CFP
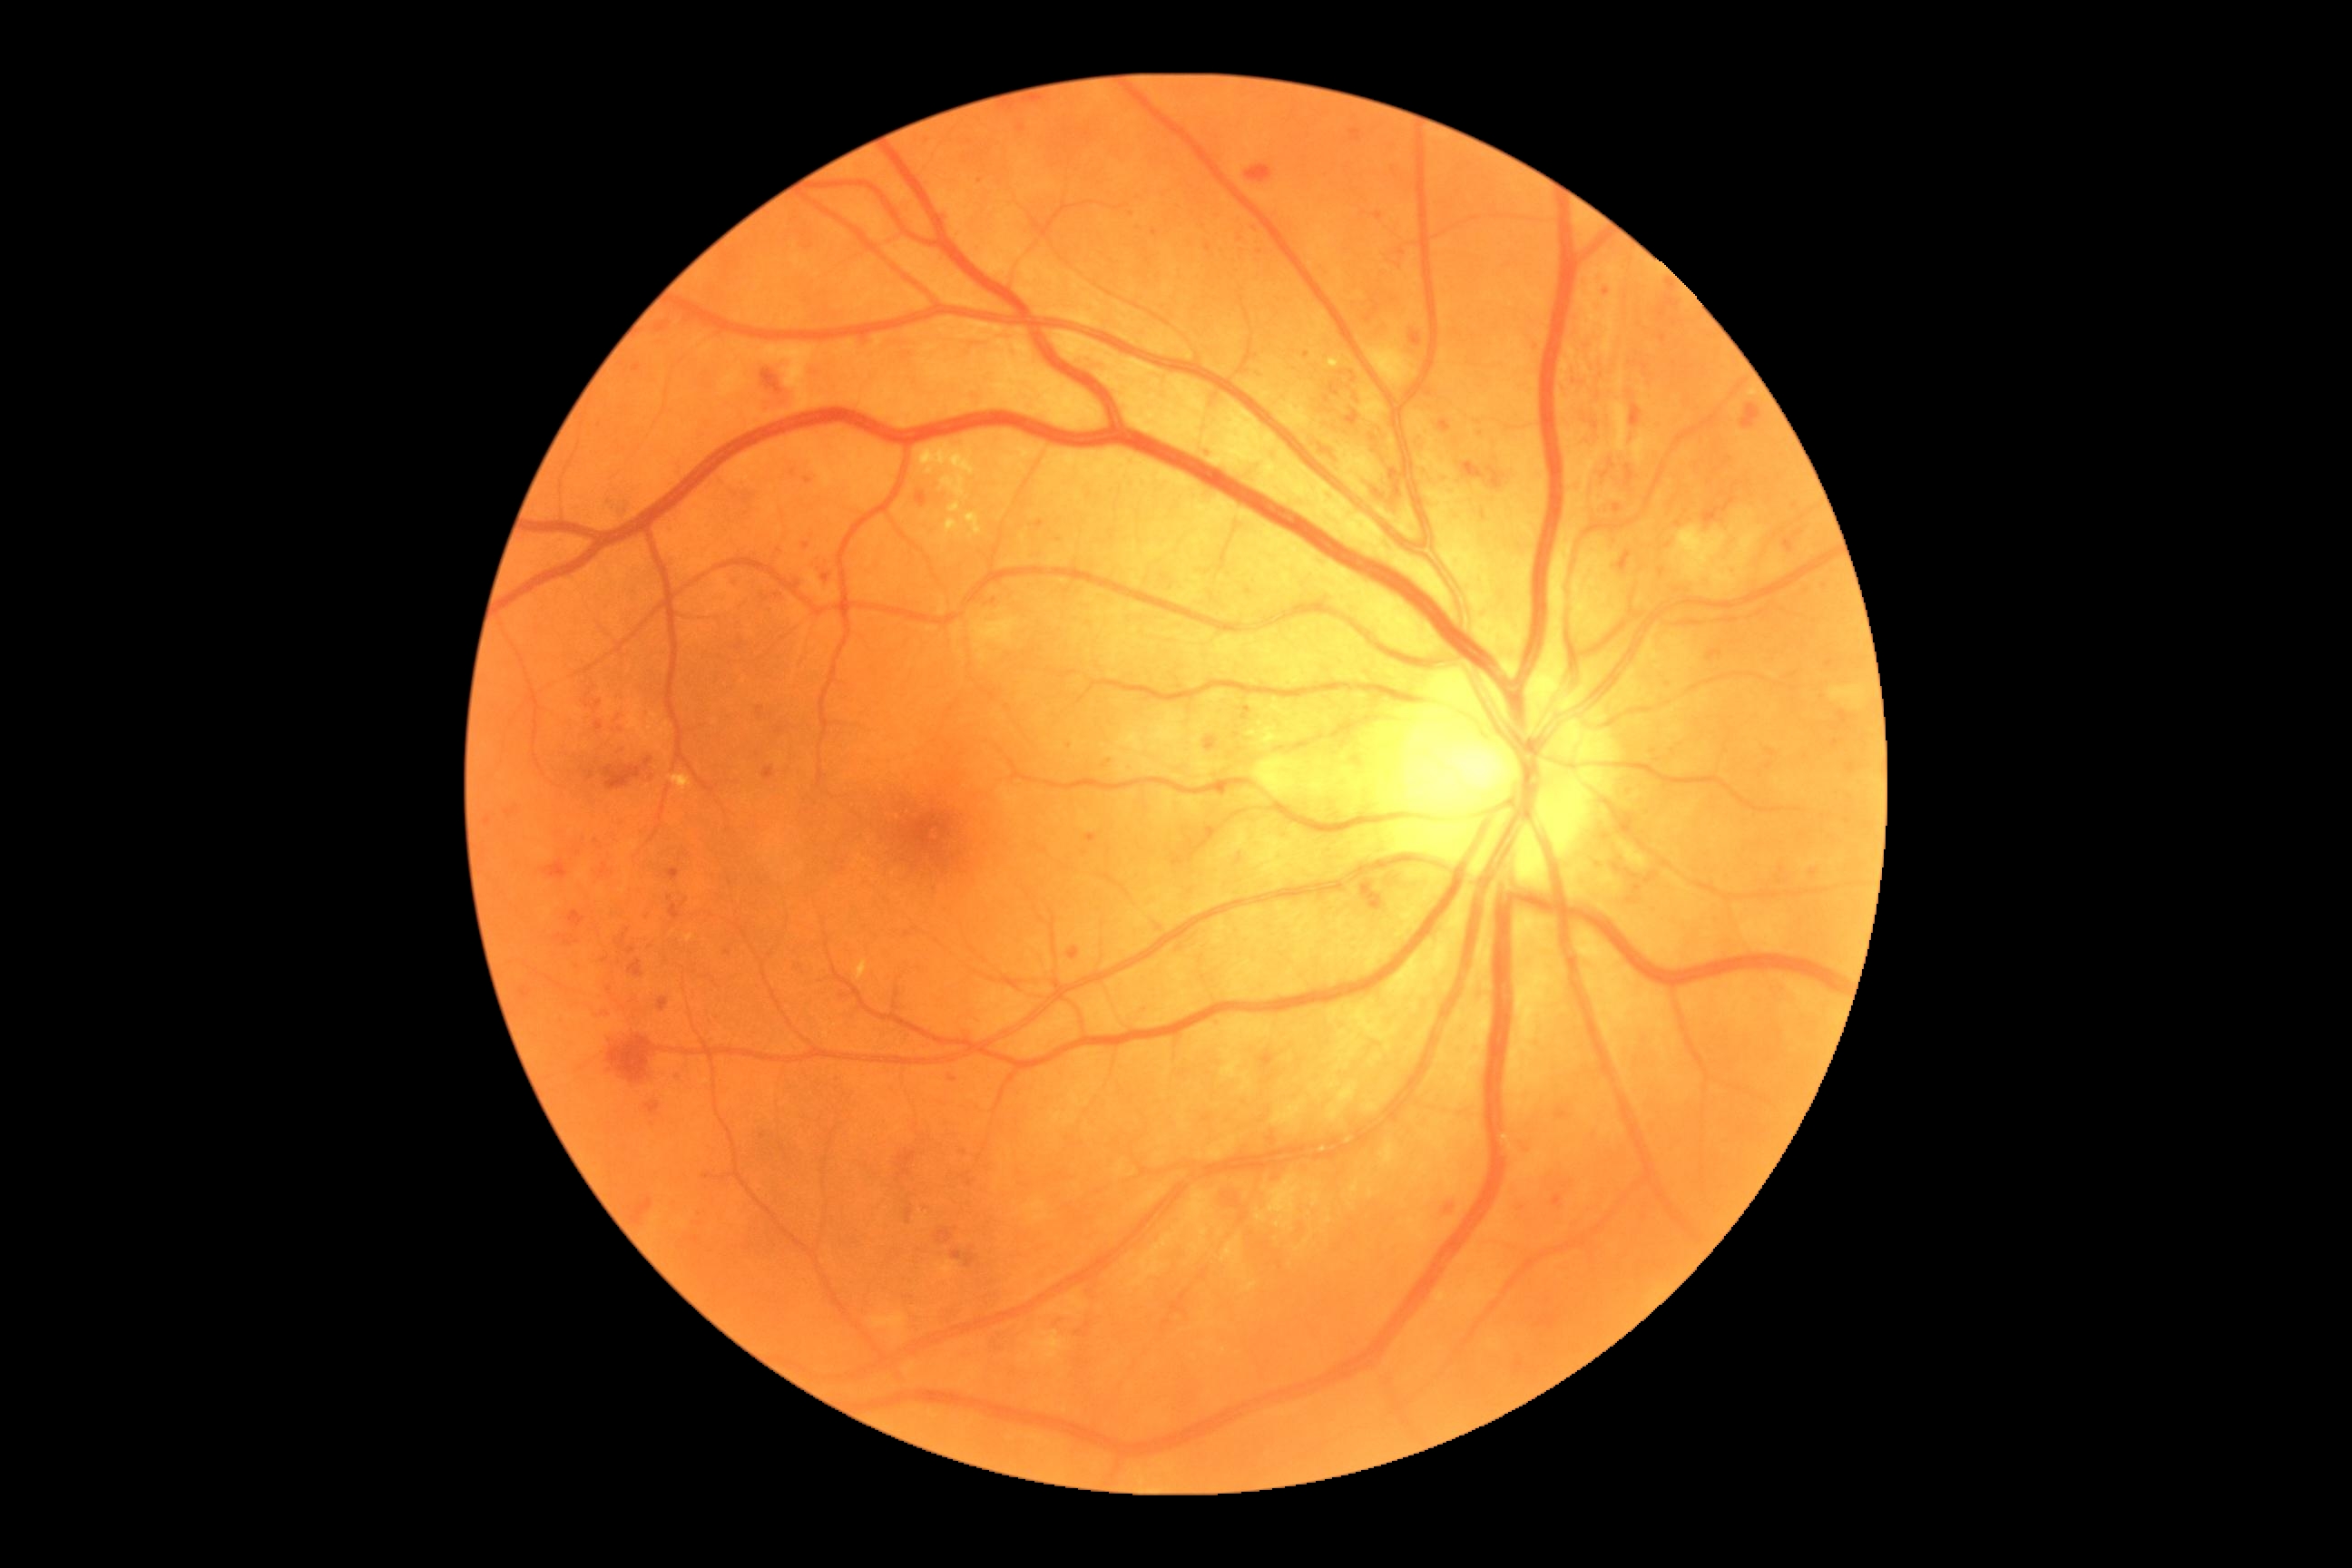 Diabetic retinopathy (DR) is grade 3 (severe NPDR)
A subset of detected lesions:
hemorrhages (HEs) (more not shown): [x1=1442, y1=1200, x2=1456, y2=1213]; [x1=821, y1=571, x2=832, y2=591]; [x1=1366, y1=480, x2=1400, y2=516]; [x1=614, y1=721, x2=629, y2=729]; [x1=772, y1=593, x2=785, y2=603]; [x1=1767, y1=749, x2=1776, y2=758]; [x1=1487, y1=467, x2=1504, y2=489]; [x1=906, y1=1208, x2=914, y2=1224]; [x1=616, y1=507, x2=627, y2=522]; [x1=1262, y1=1054, x2=1275, y2=1070]; [x1=671, y1=905, x2=681, y2=921]; [x1=1360, y1=881, x2=1384, y2=908]; [x1=763, y1=767, x2=776, y2=779]; [x1=1629, y1=406, x2=1642, y2=427]; [x1=1741, y1=404, x2=1761, y2=429]; [x1=758, y1=707, x2=765, y2=718]; [x1=1440, y1=476, x2=1449, y2=482]; [x1=1556, y1=1108, x2=1569, y2=1119]; [x1=794, y1=578, x2=803, y2=591]
Small HEs approximately at 1483/517